Acquired on the Natus RetCam Envision. Pediatric retinal photograph (wide-field) — 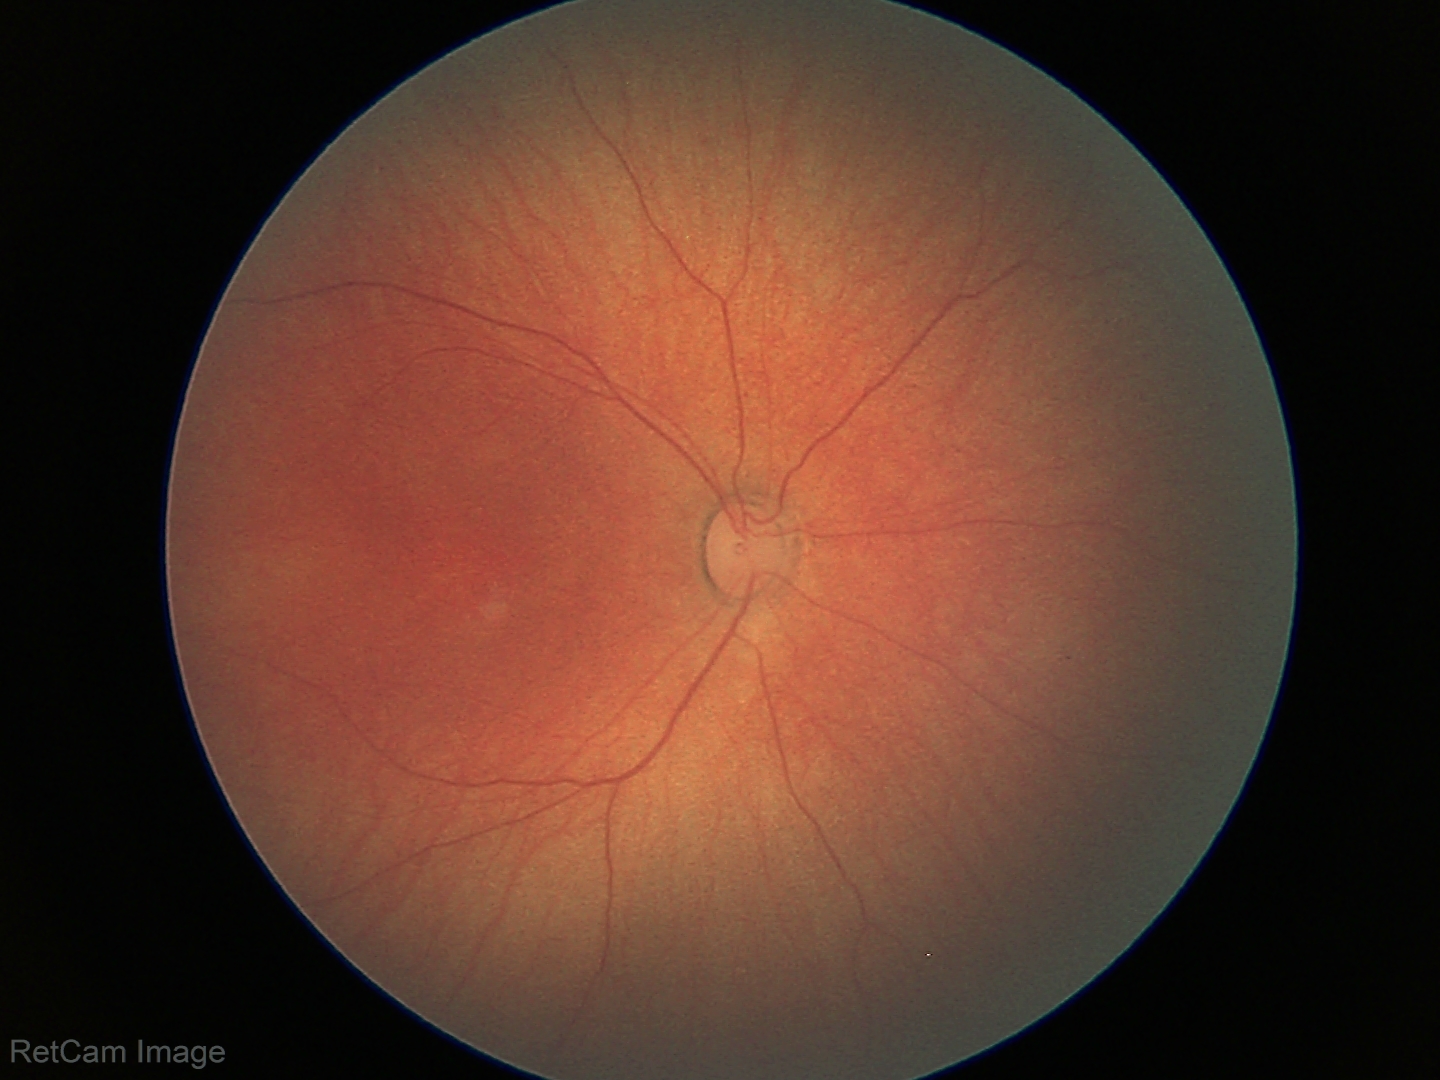 Impression = physiological appearance